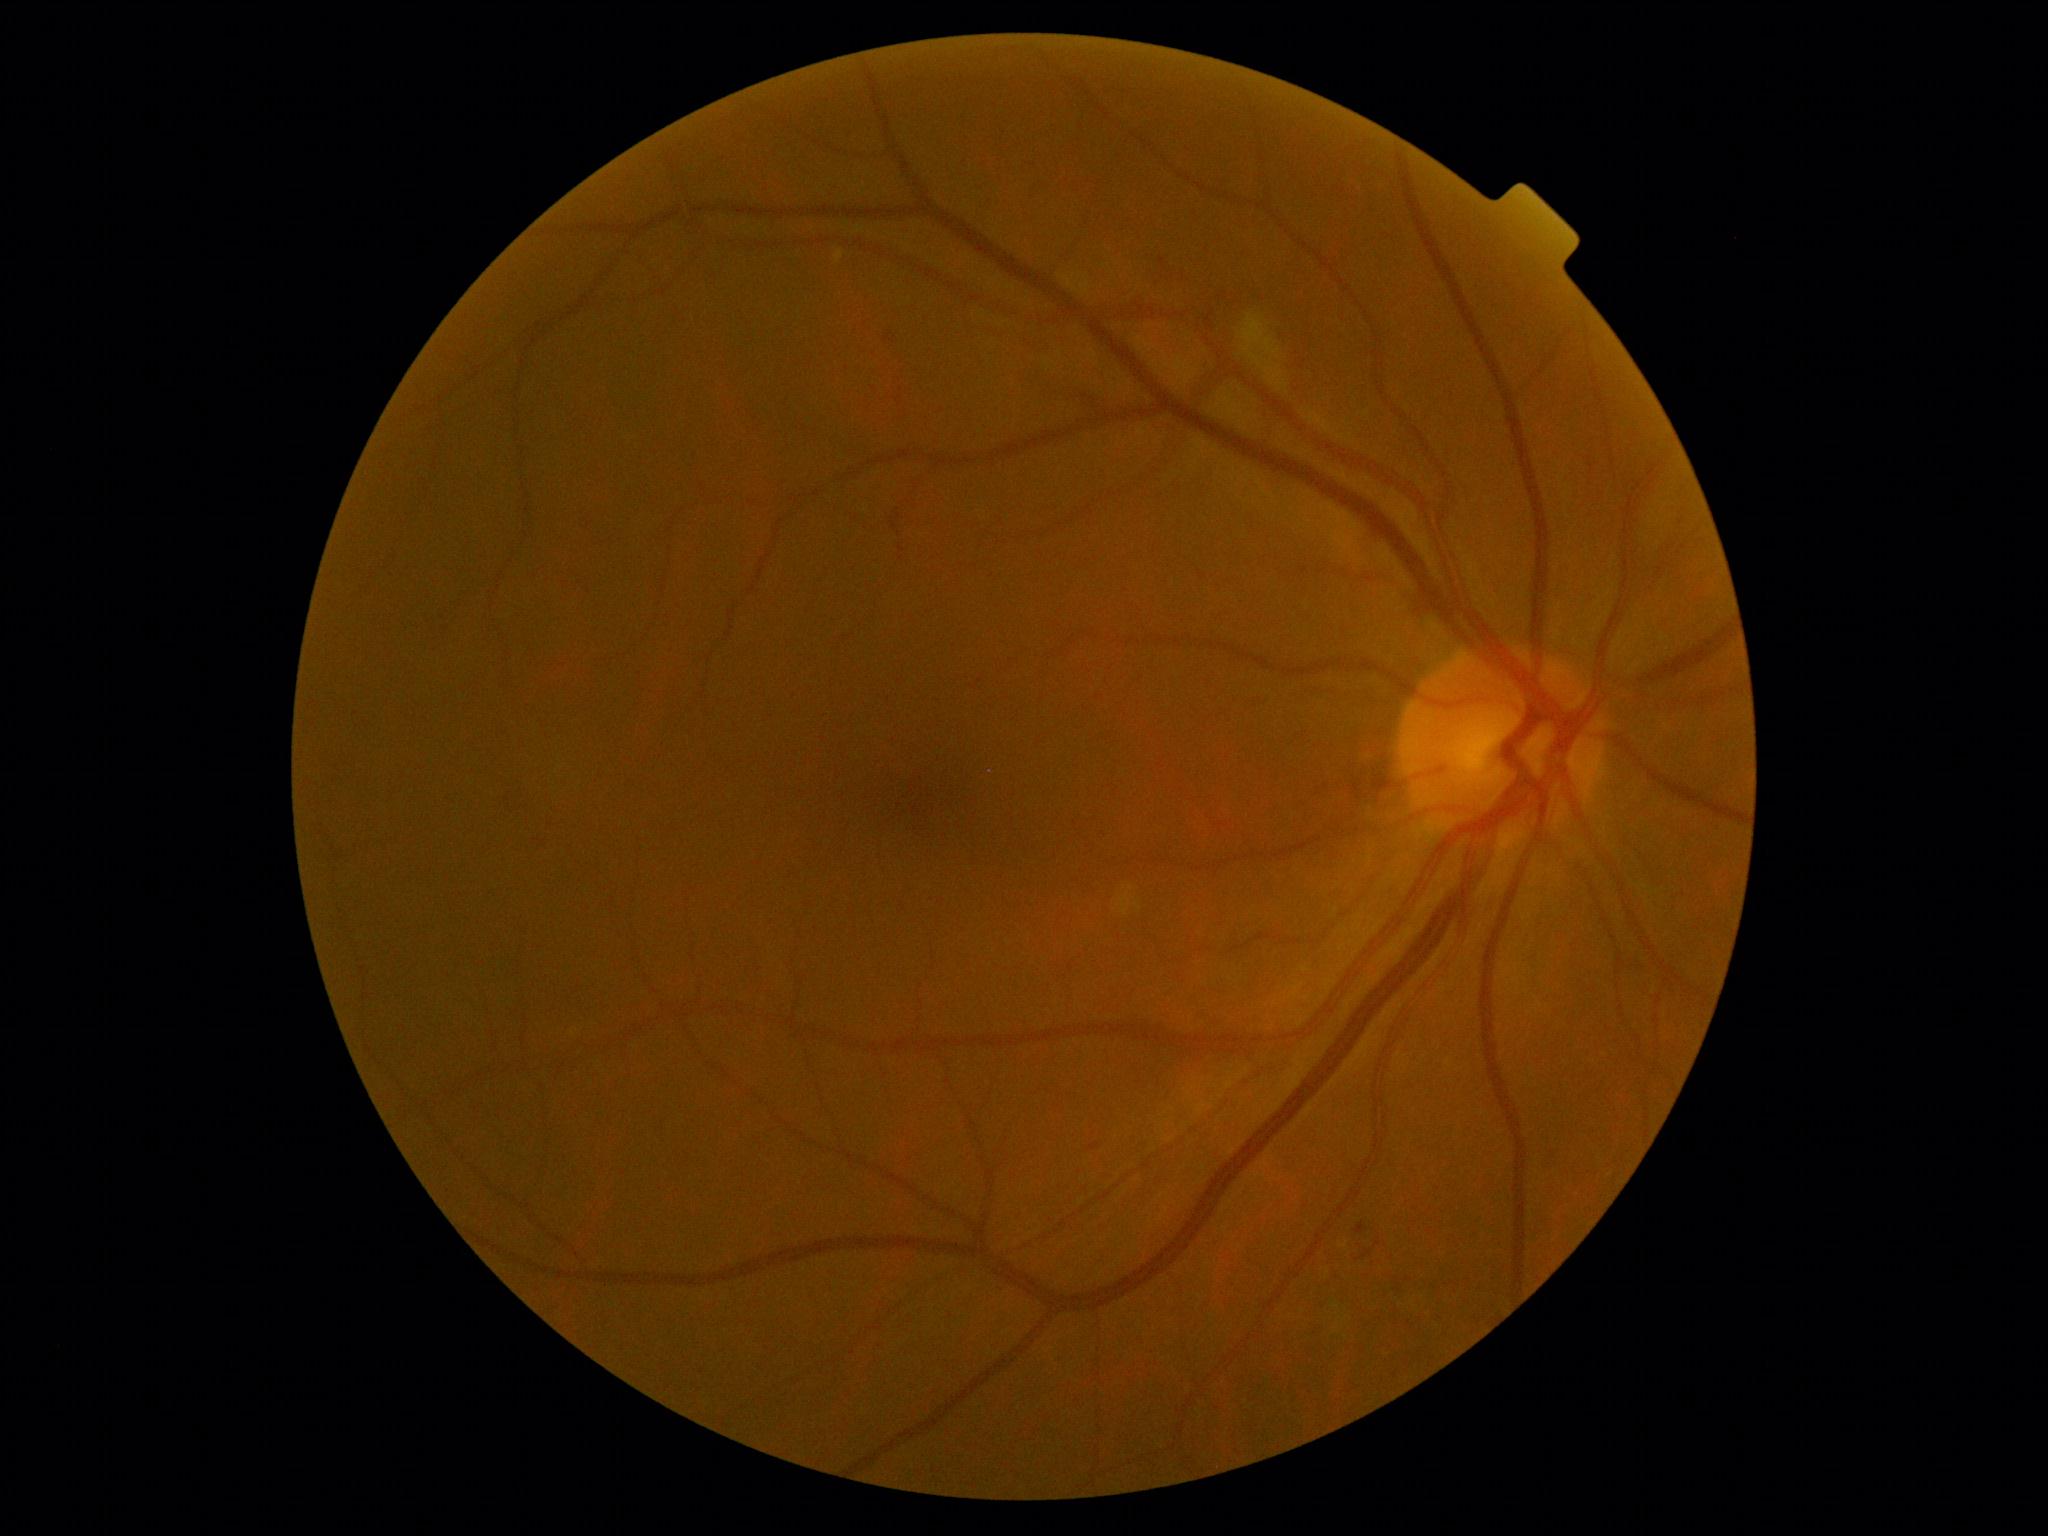

Retinopathy grade is 2.